Pediatric retinal photograph (wide-field); image size 640x480
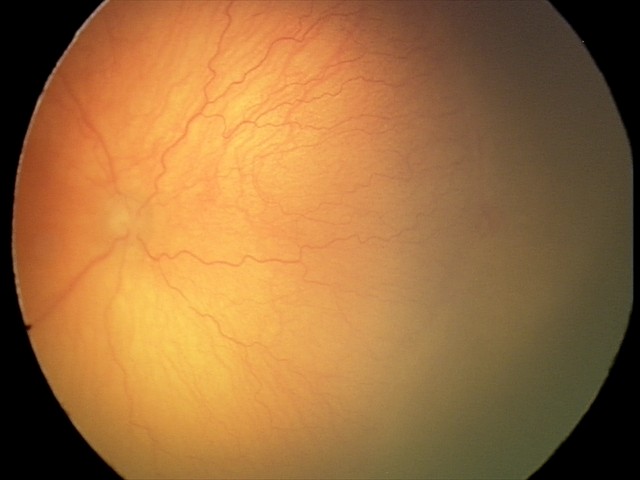

With plus disease.
Screening series with aggressive retinopathy of prematurity (A-ROP).